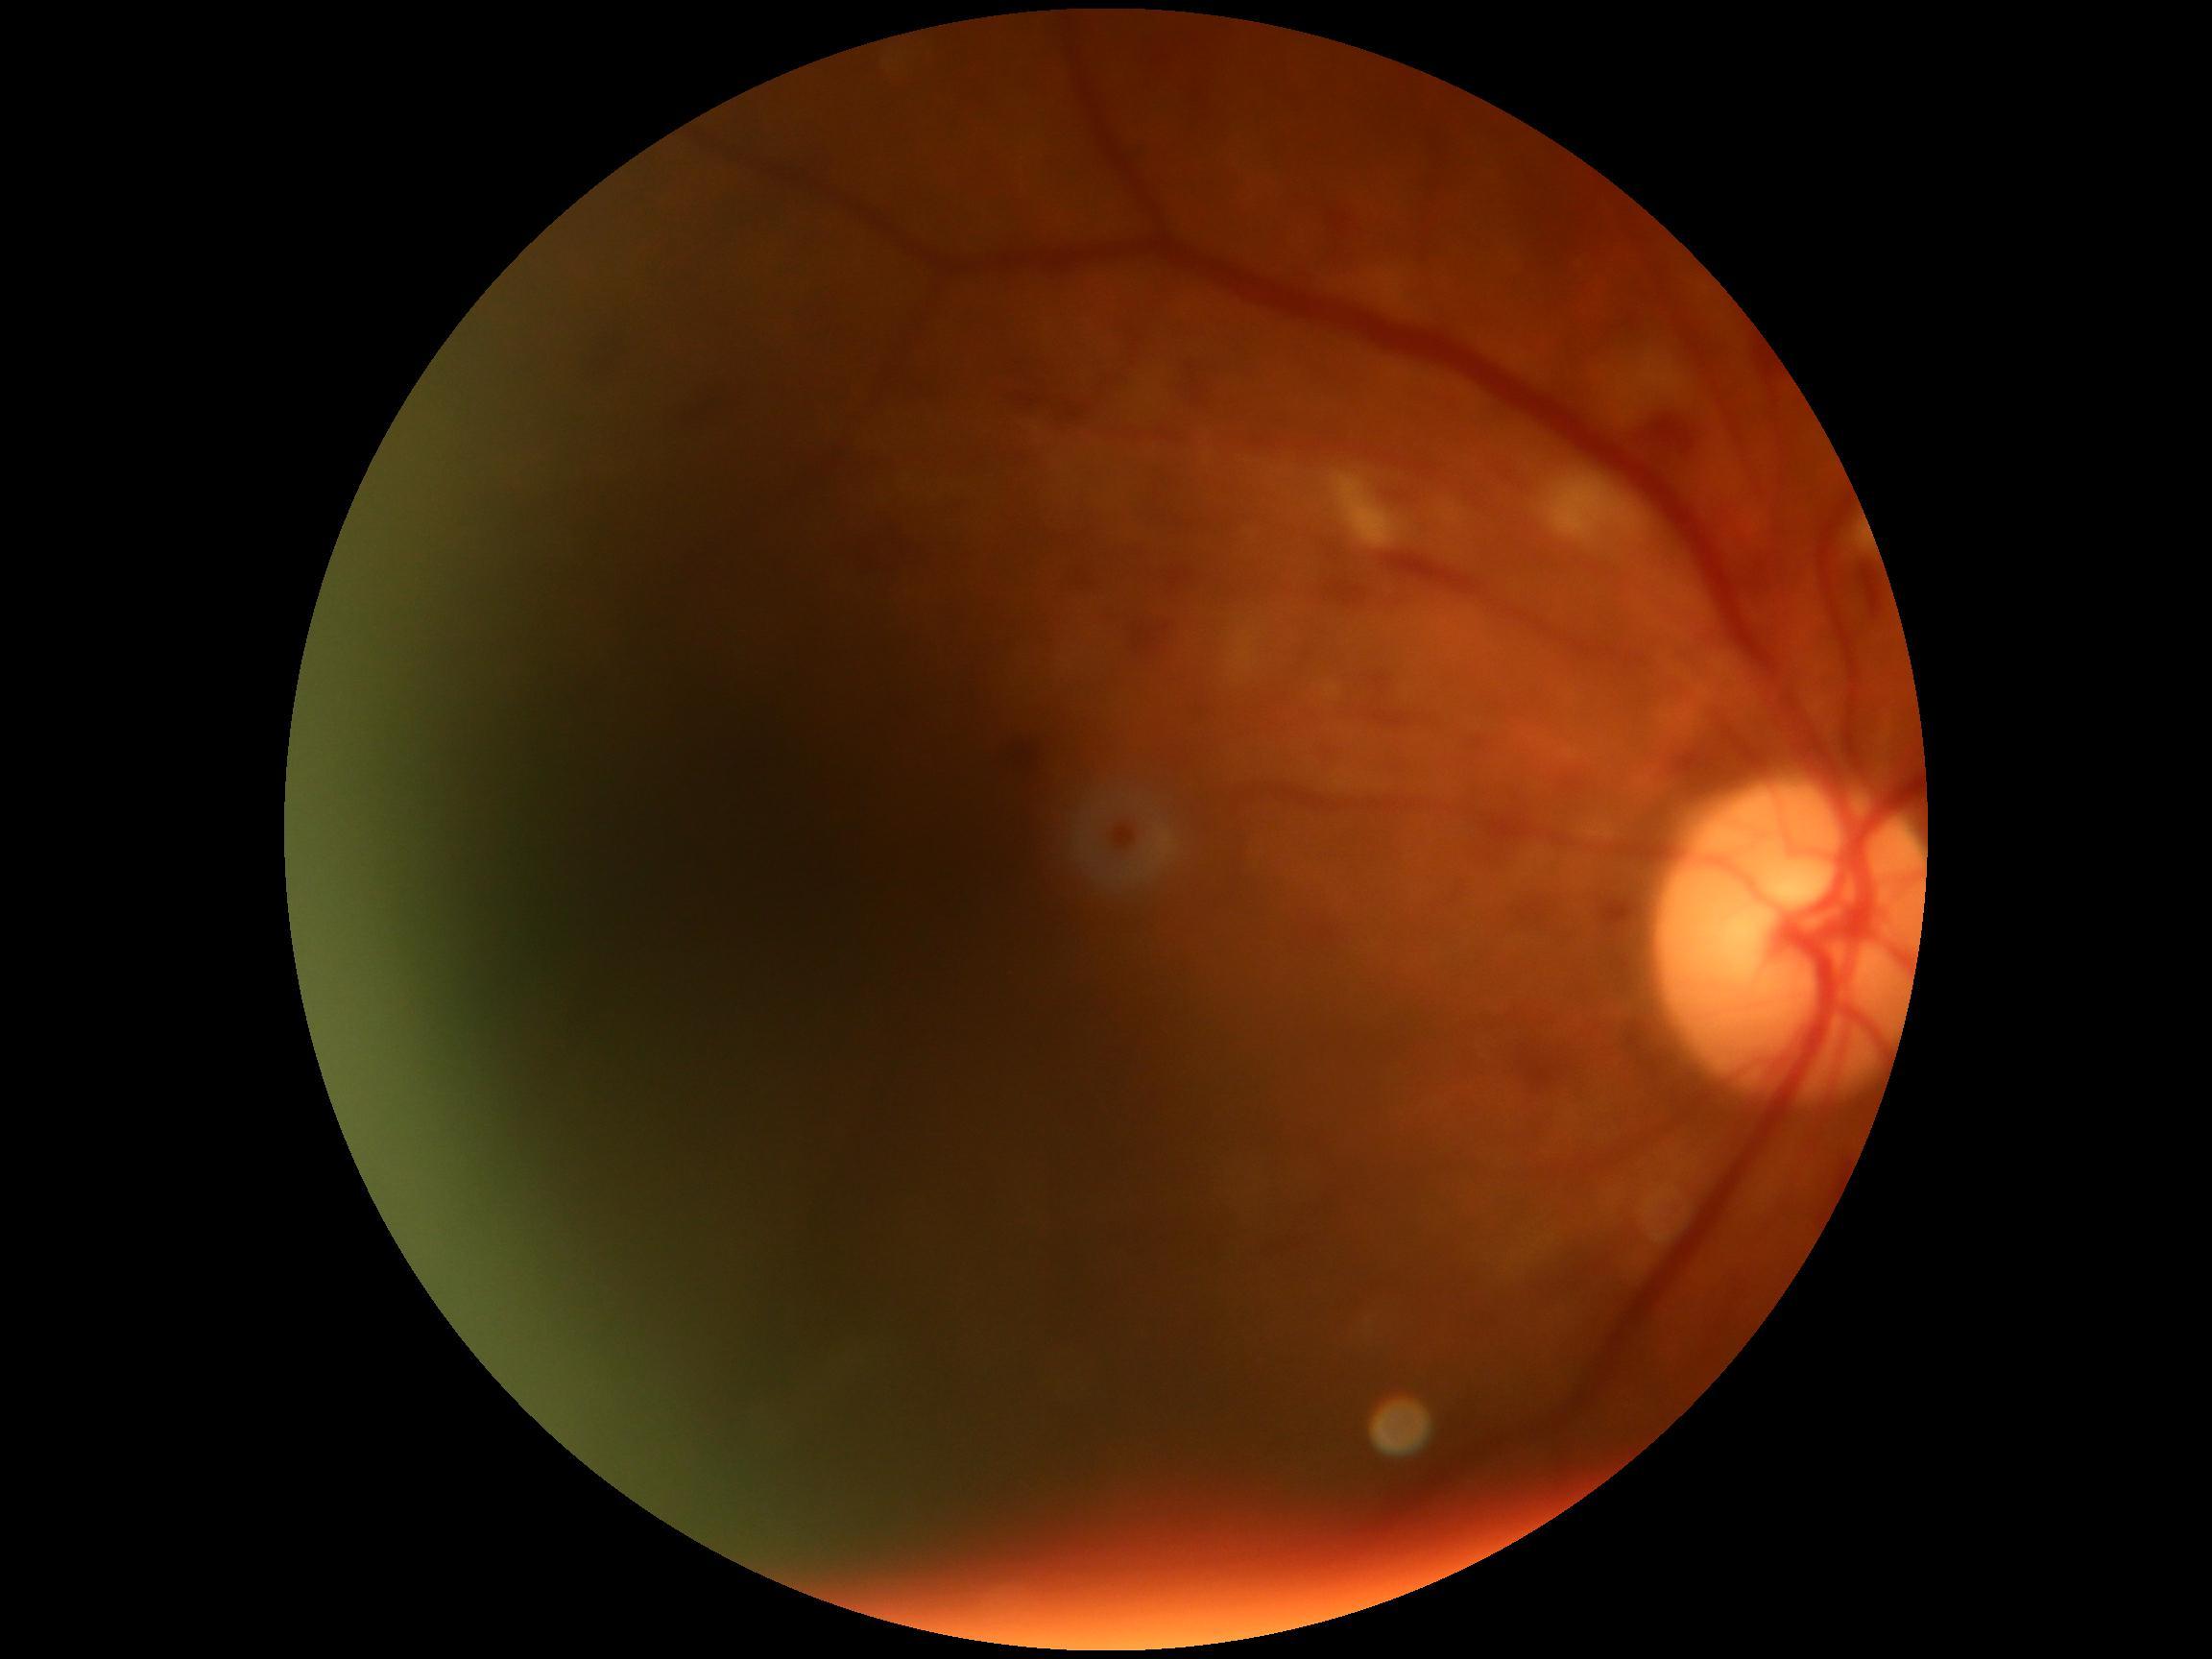

DR class: non-proliferative diabetic retinopathy.
DR: moderate NPDR (grade 2).